Captured with the Phoenix ICON (100° field of view) · infant wide-field retinal image.
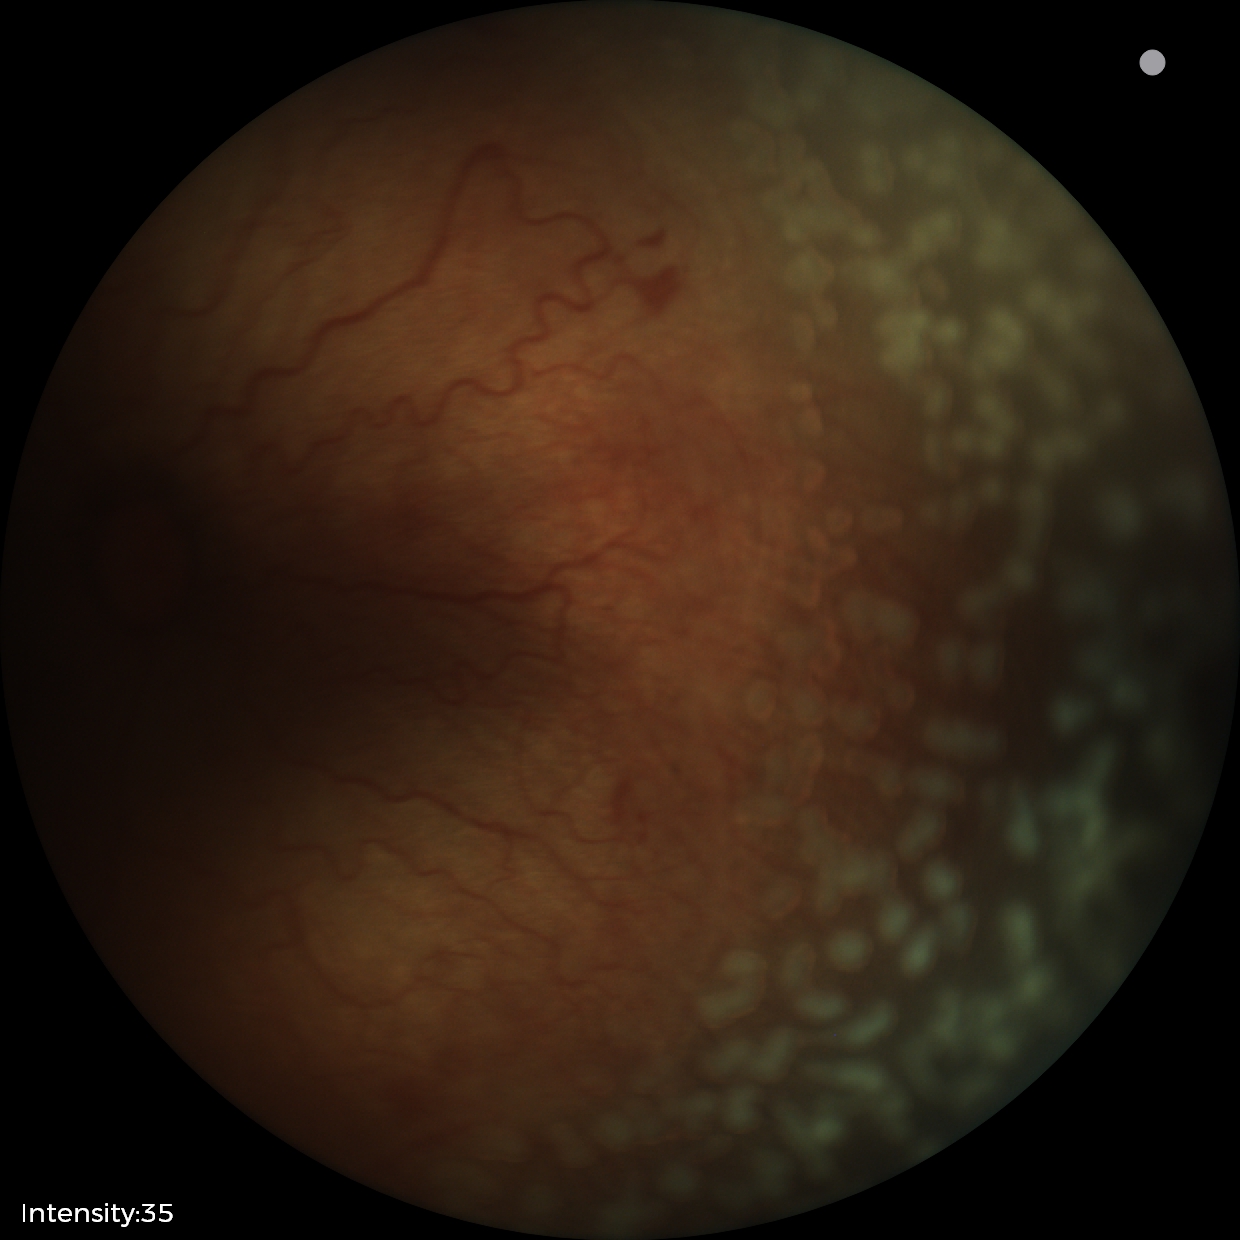
Q: What was the screening finding?
A: retinopathy of prematurity stage 2